45° FOV. 2048x1536.
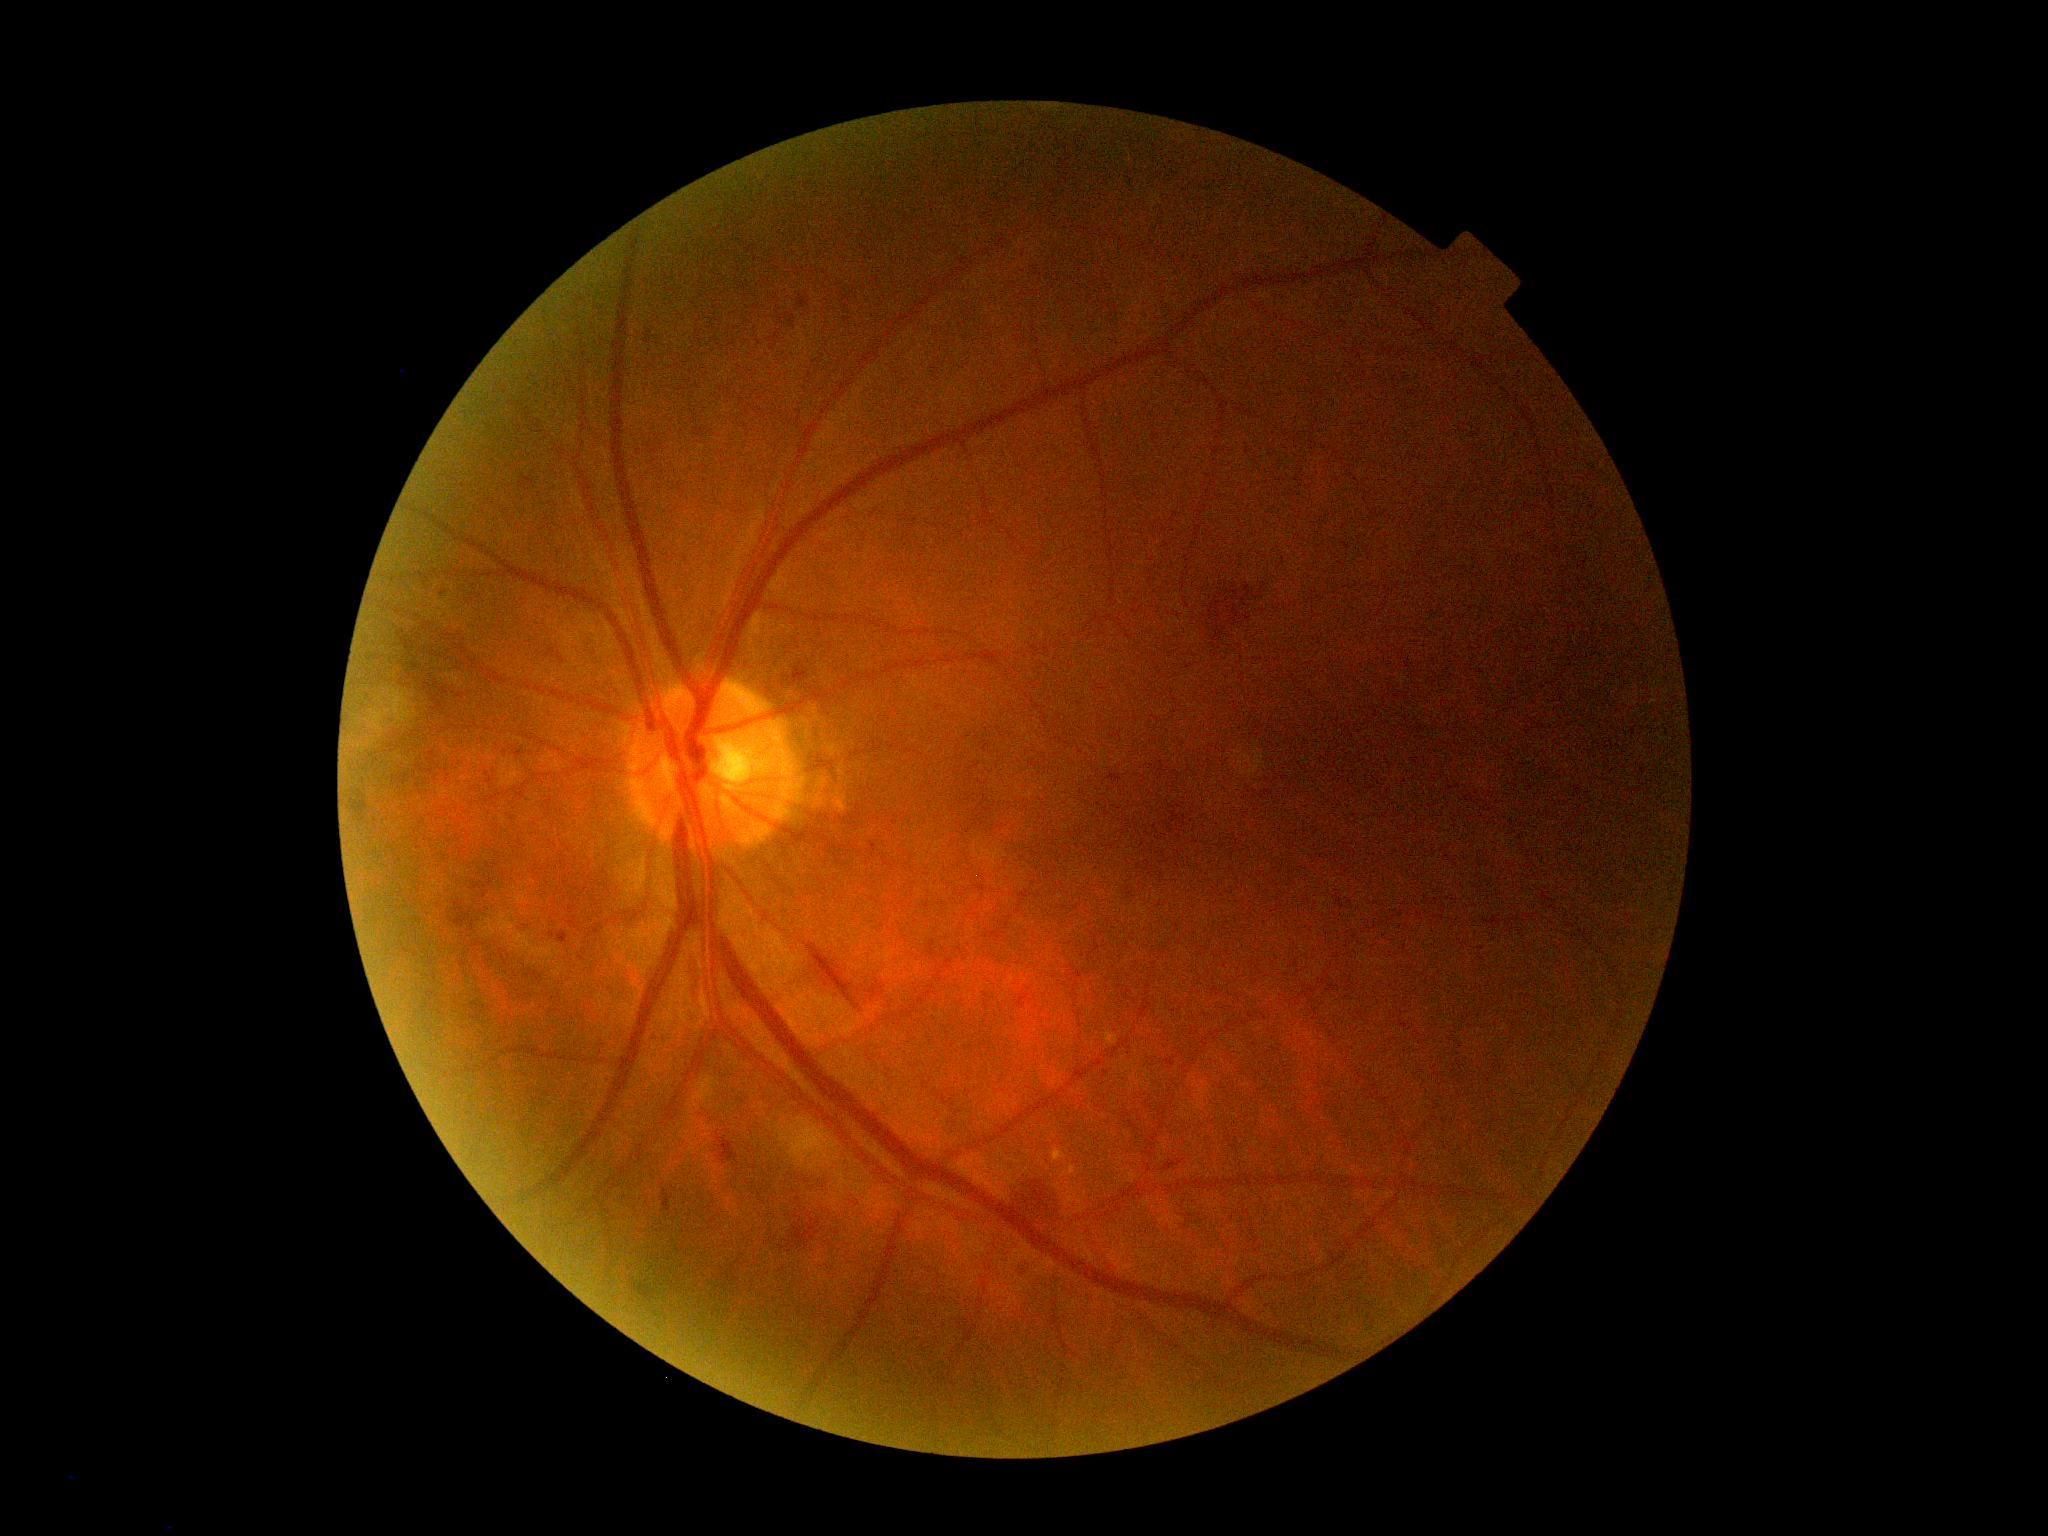
DR stage is grade 2 — more than just microaneurysms but less than severe NPDR.